NIDEK AFC-230 · diabetic retinopathy graded by the modified Davis classification
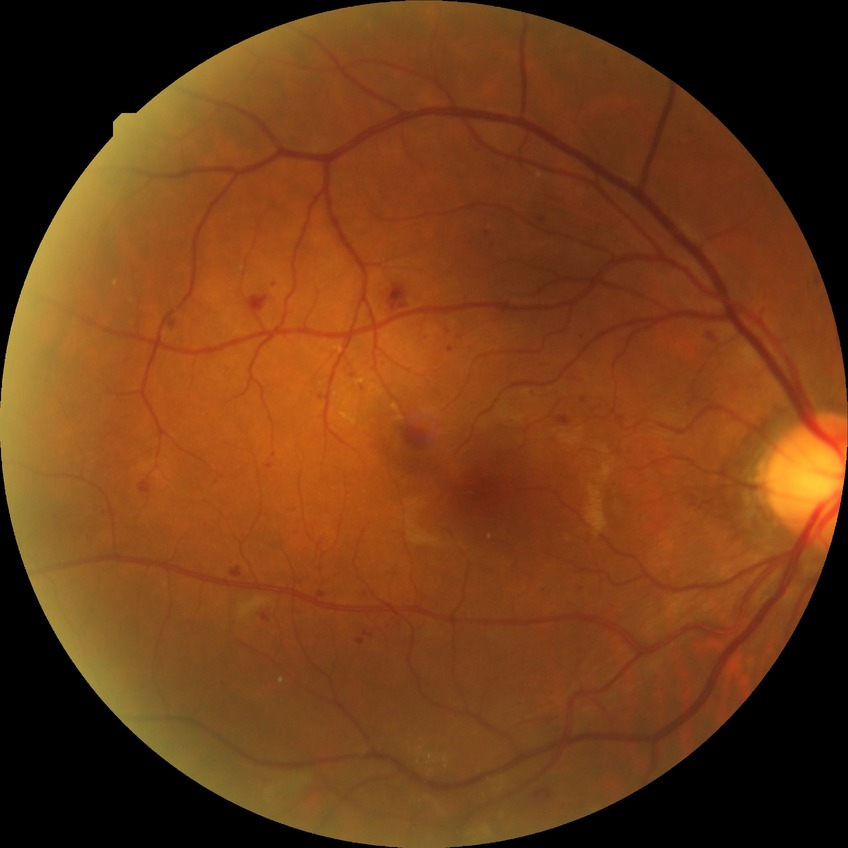
Diabetic retinopathy (DR): simple diabetic retinopathy (SDR).